Modified Davis classification. Nonmydriatic fundus photograph: 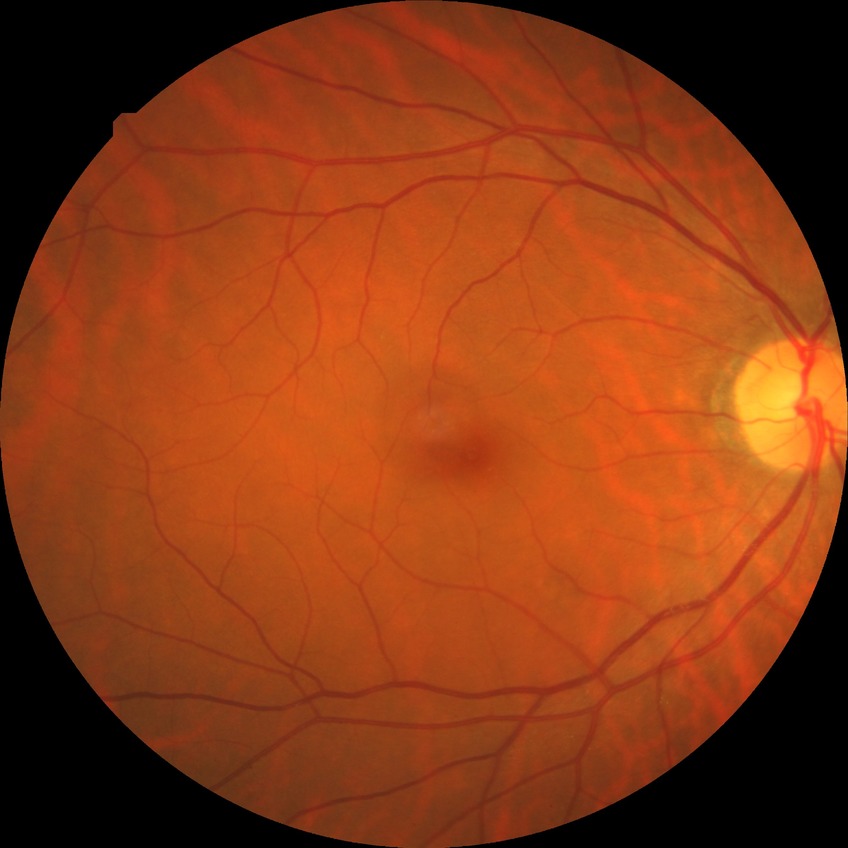 • diabetic retinopathy (DR): NDR (no diabetic retinopathy)